Color fundus image.
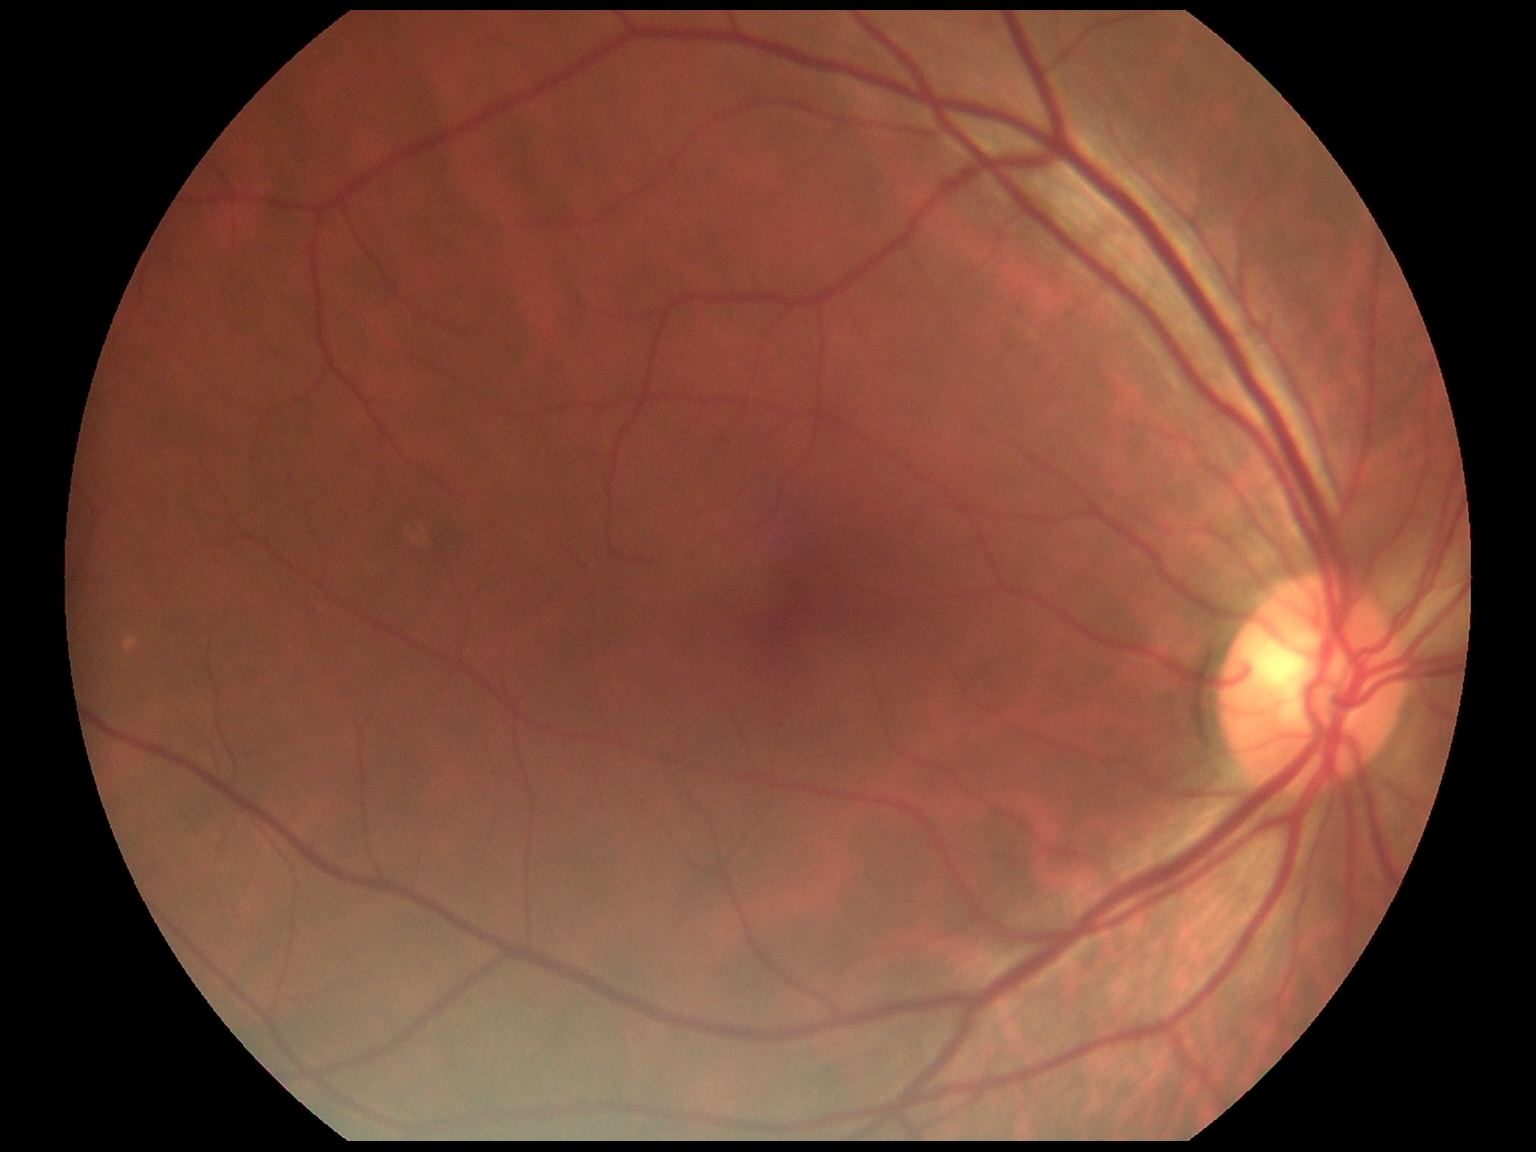

  dr_grade: no apparent retinopathy (0) — no visible signs of diabetic retinopathy